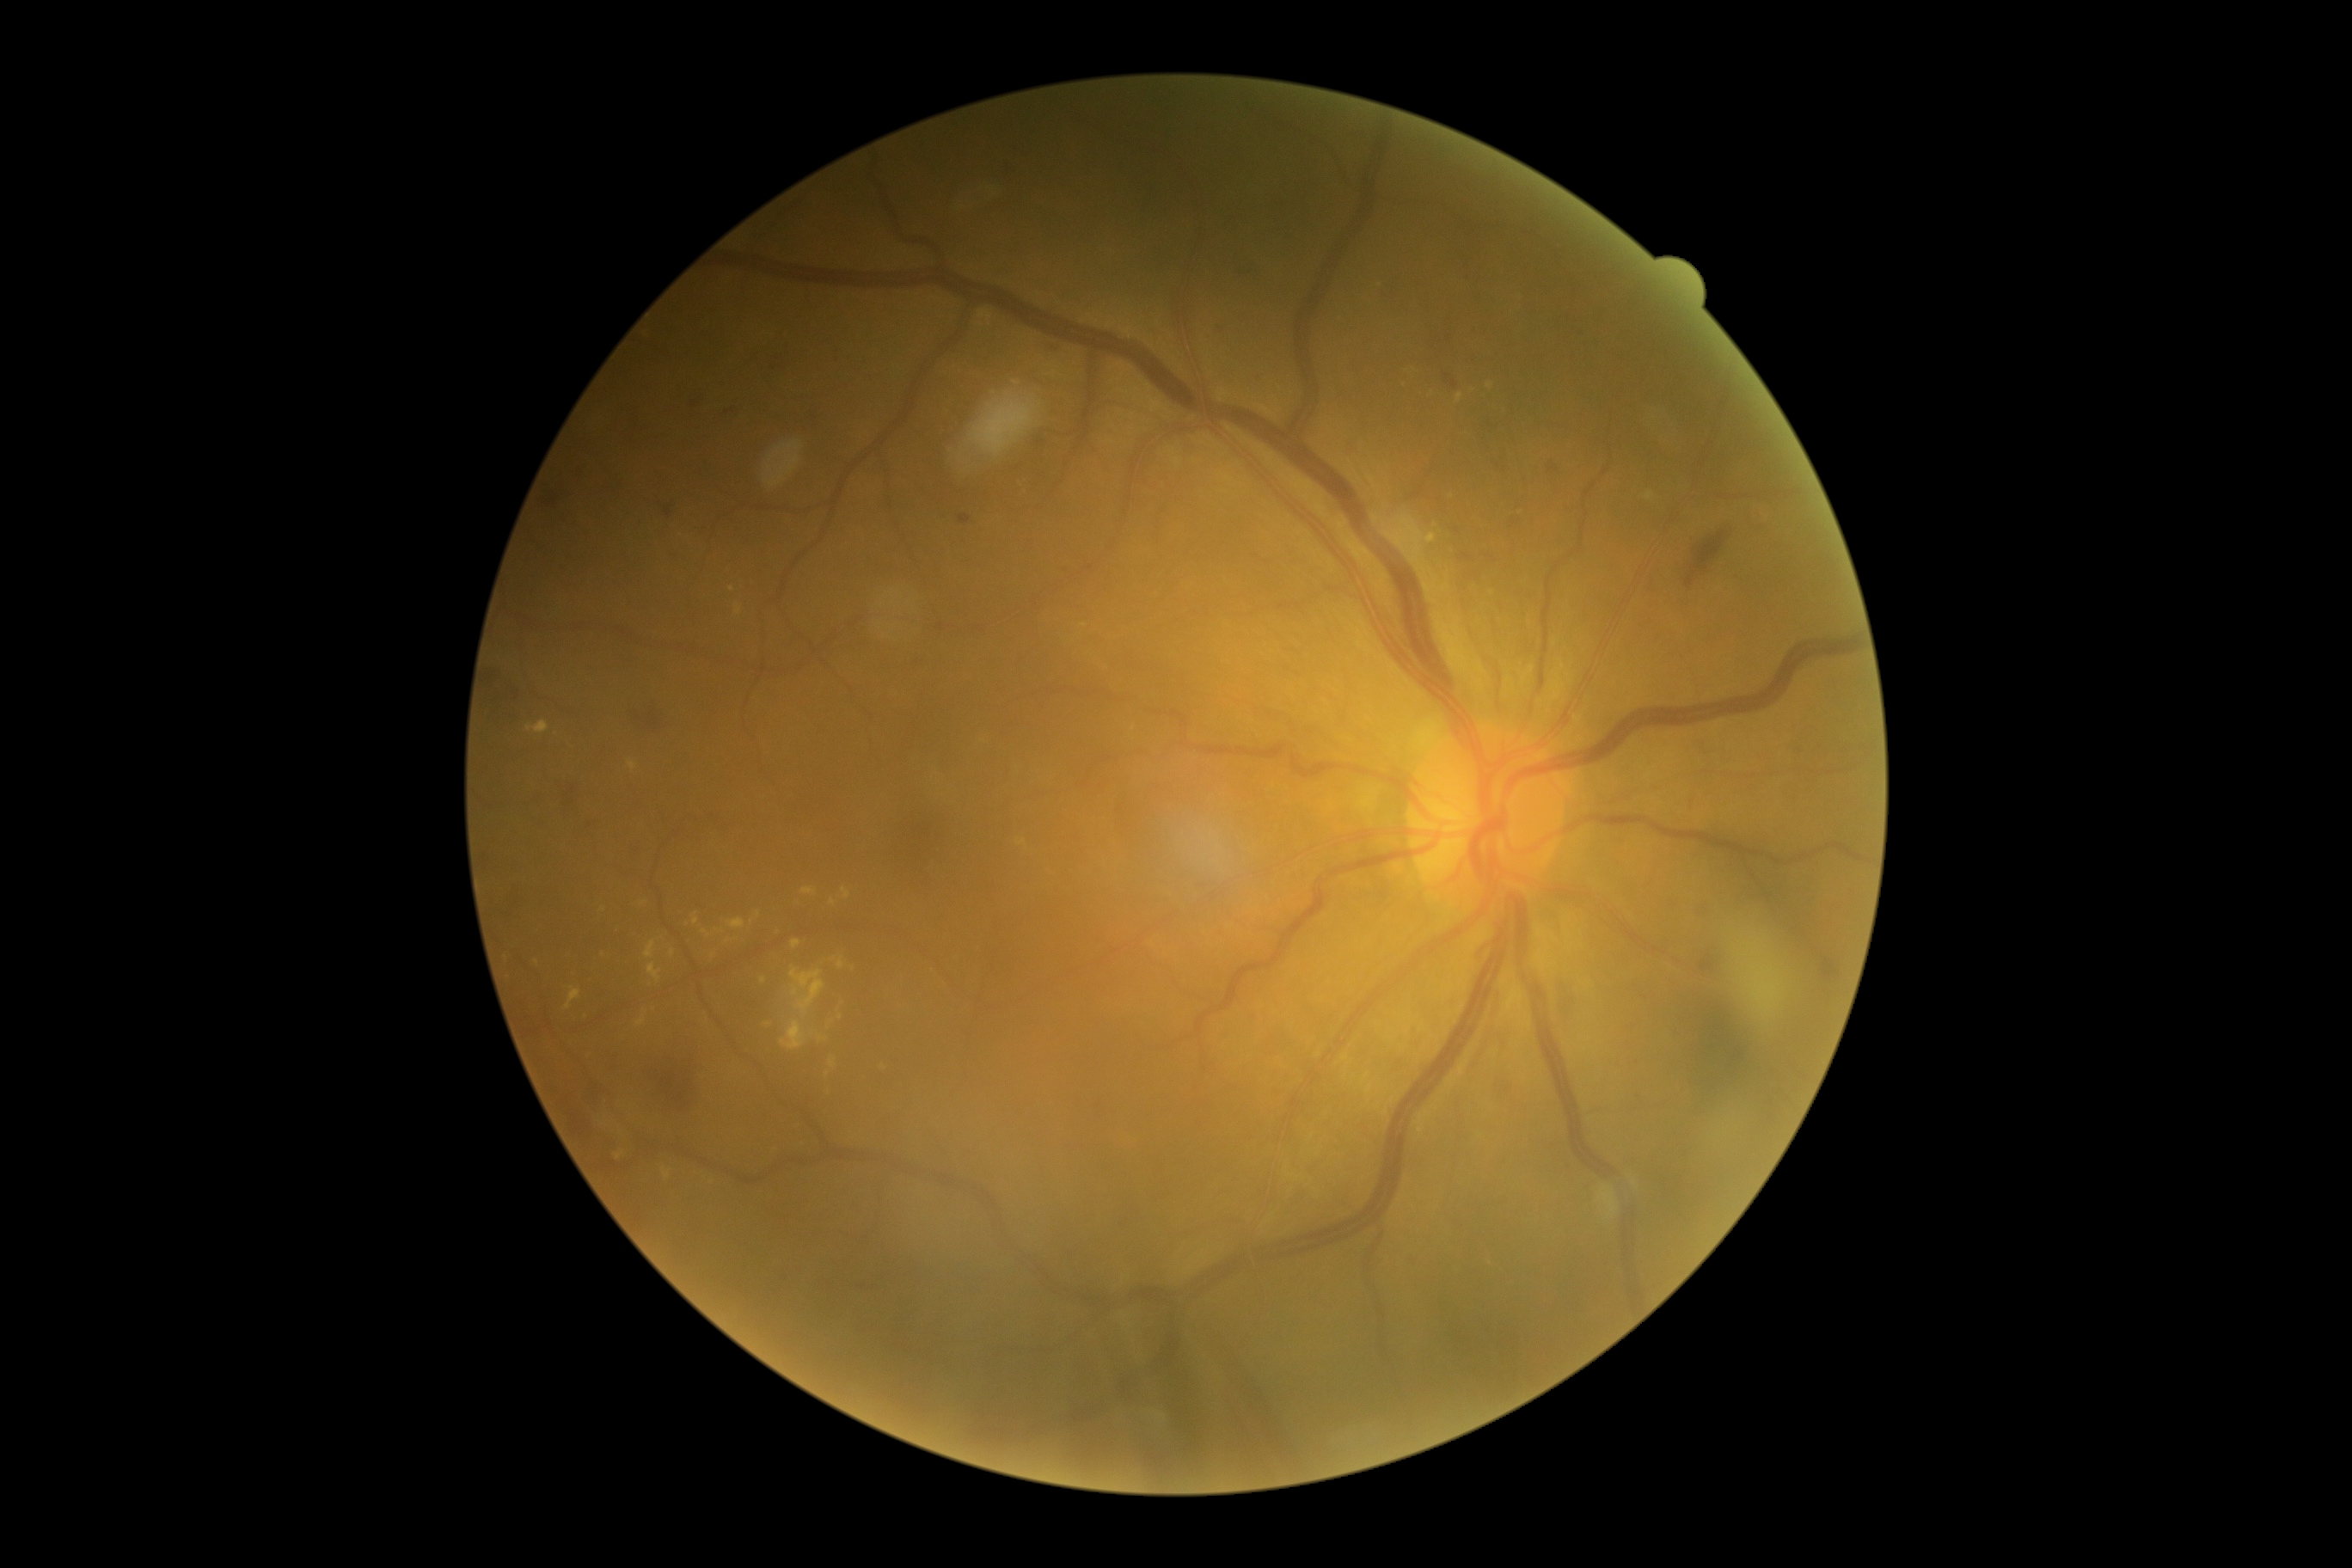

DR severity: 2.